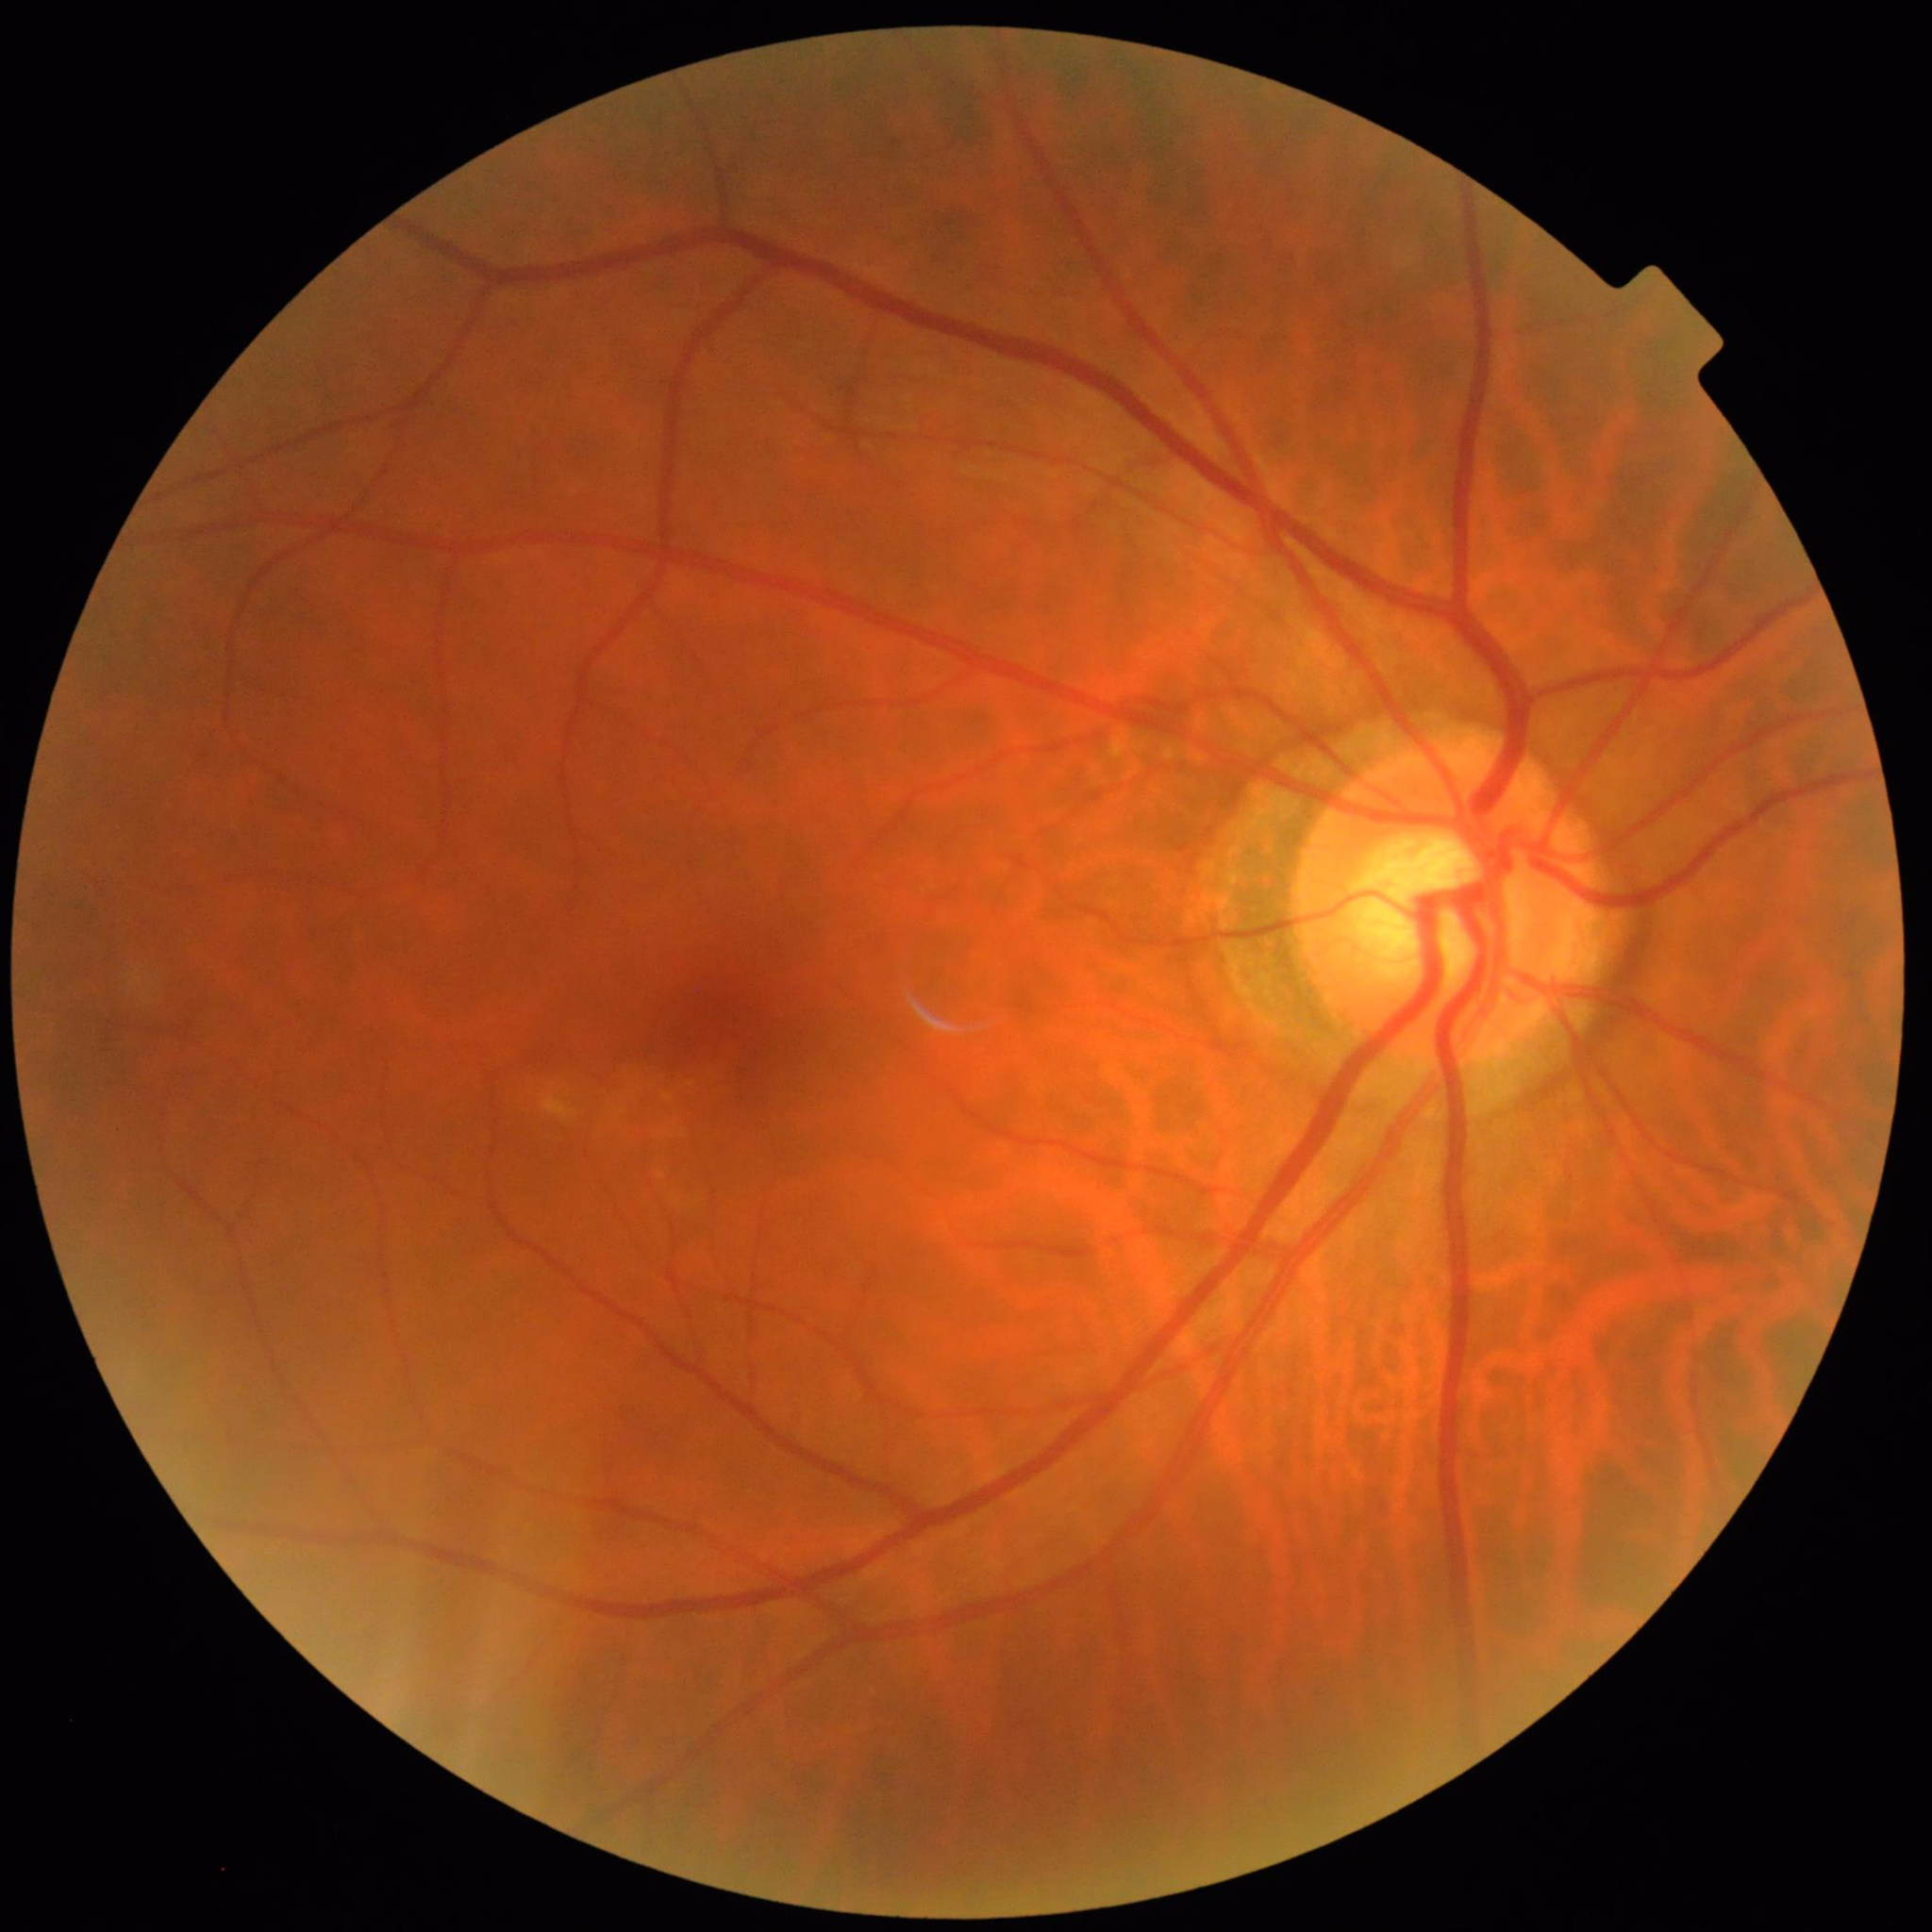
Image quality: no concerns identified; Condition: diabetic retinopathy.